Infant wide-field retinal image · 1240 by 1240 pixels · 100° field of view (Phoenix ICON).
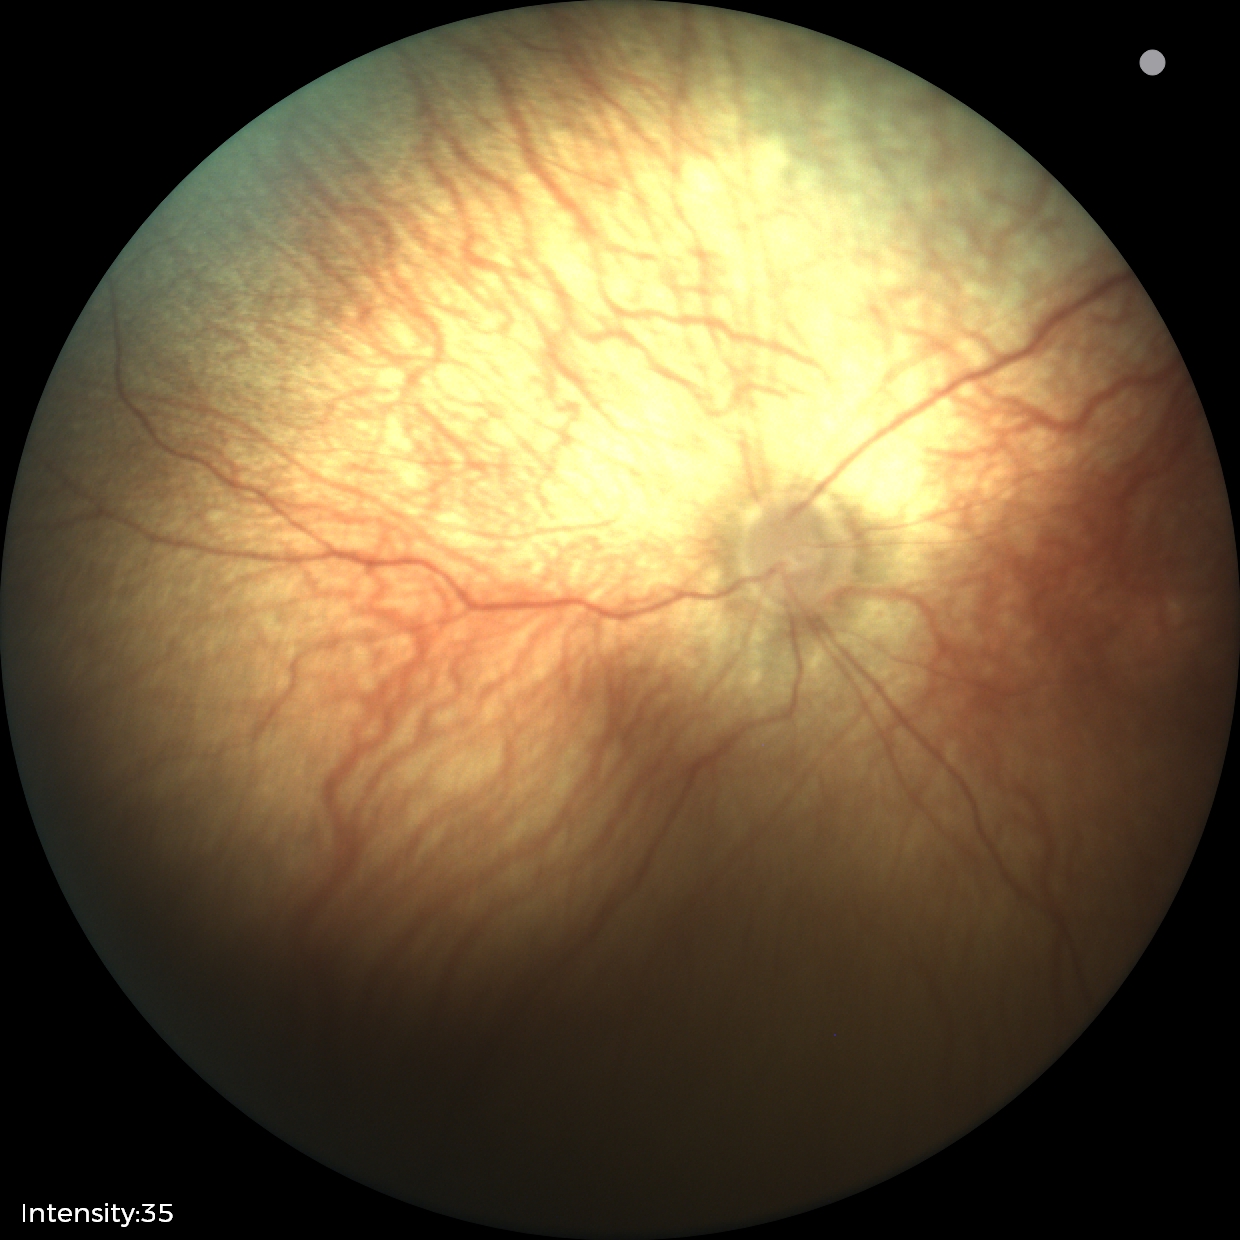 Screening examination with no abnormal retinal findings.